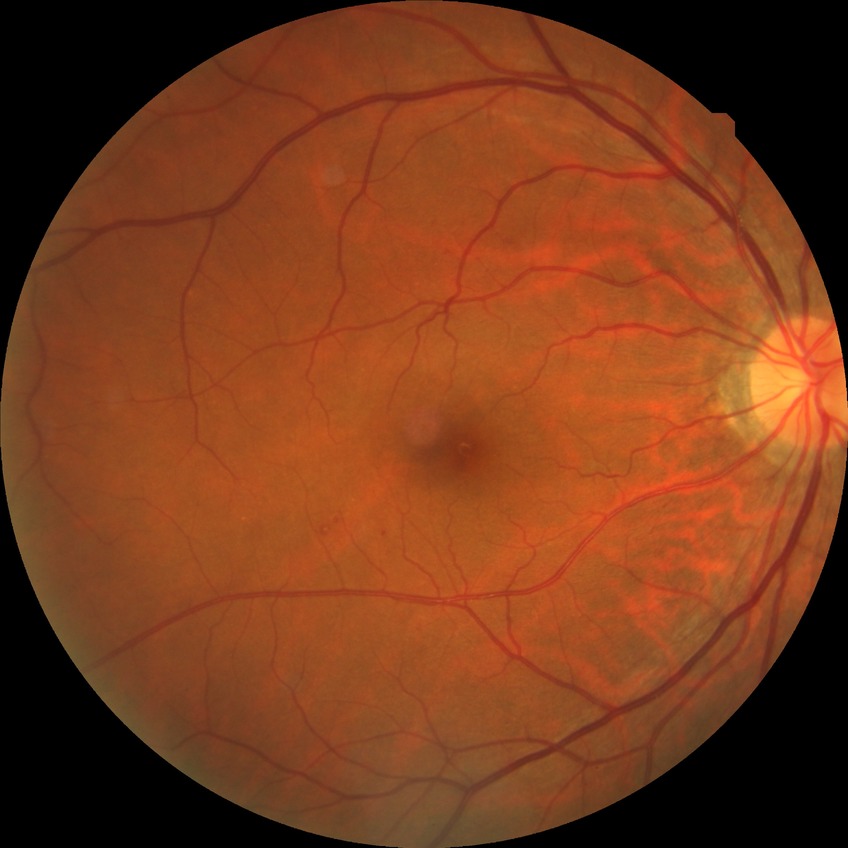

DR grade is SDR.